45-degree field of view; CFP — 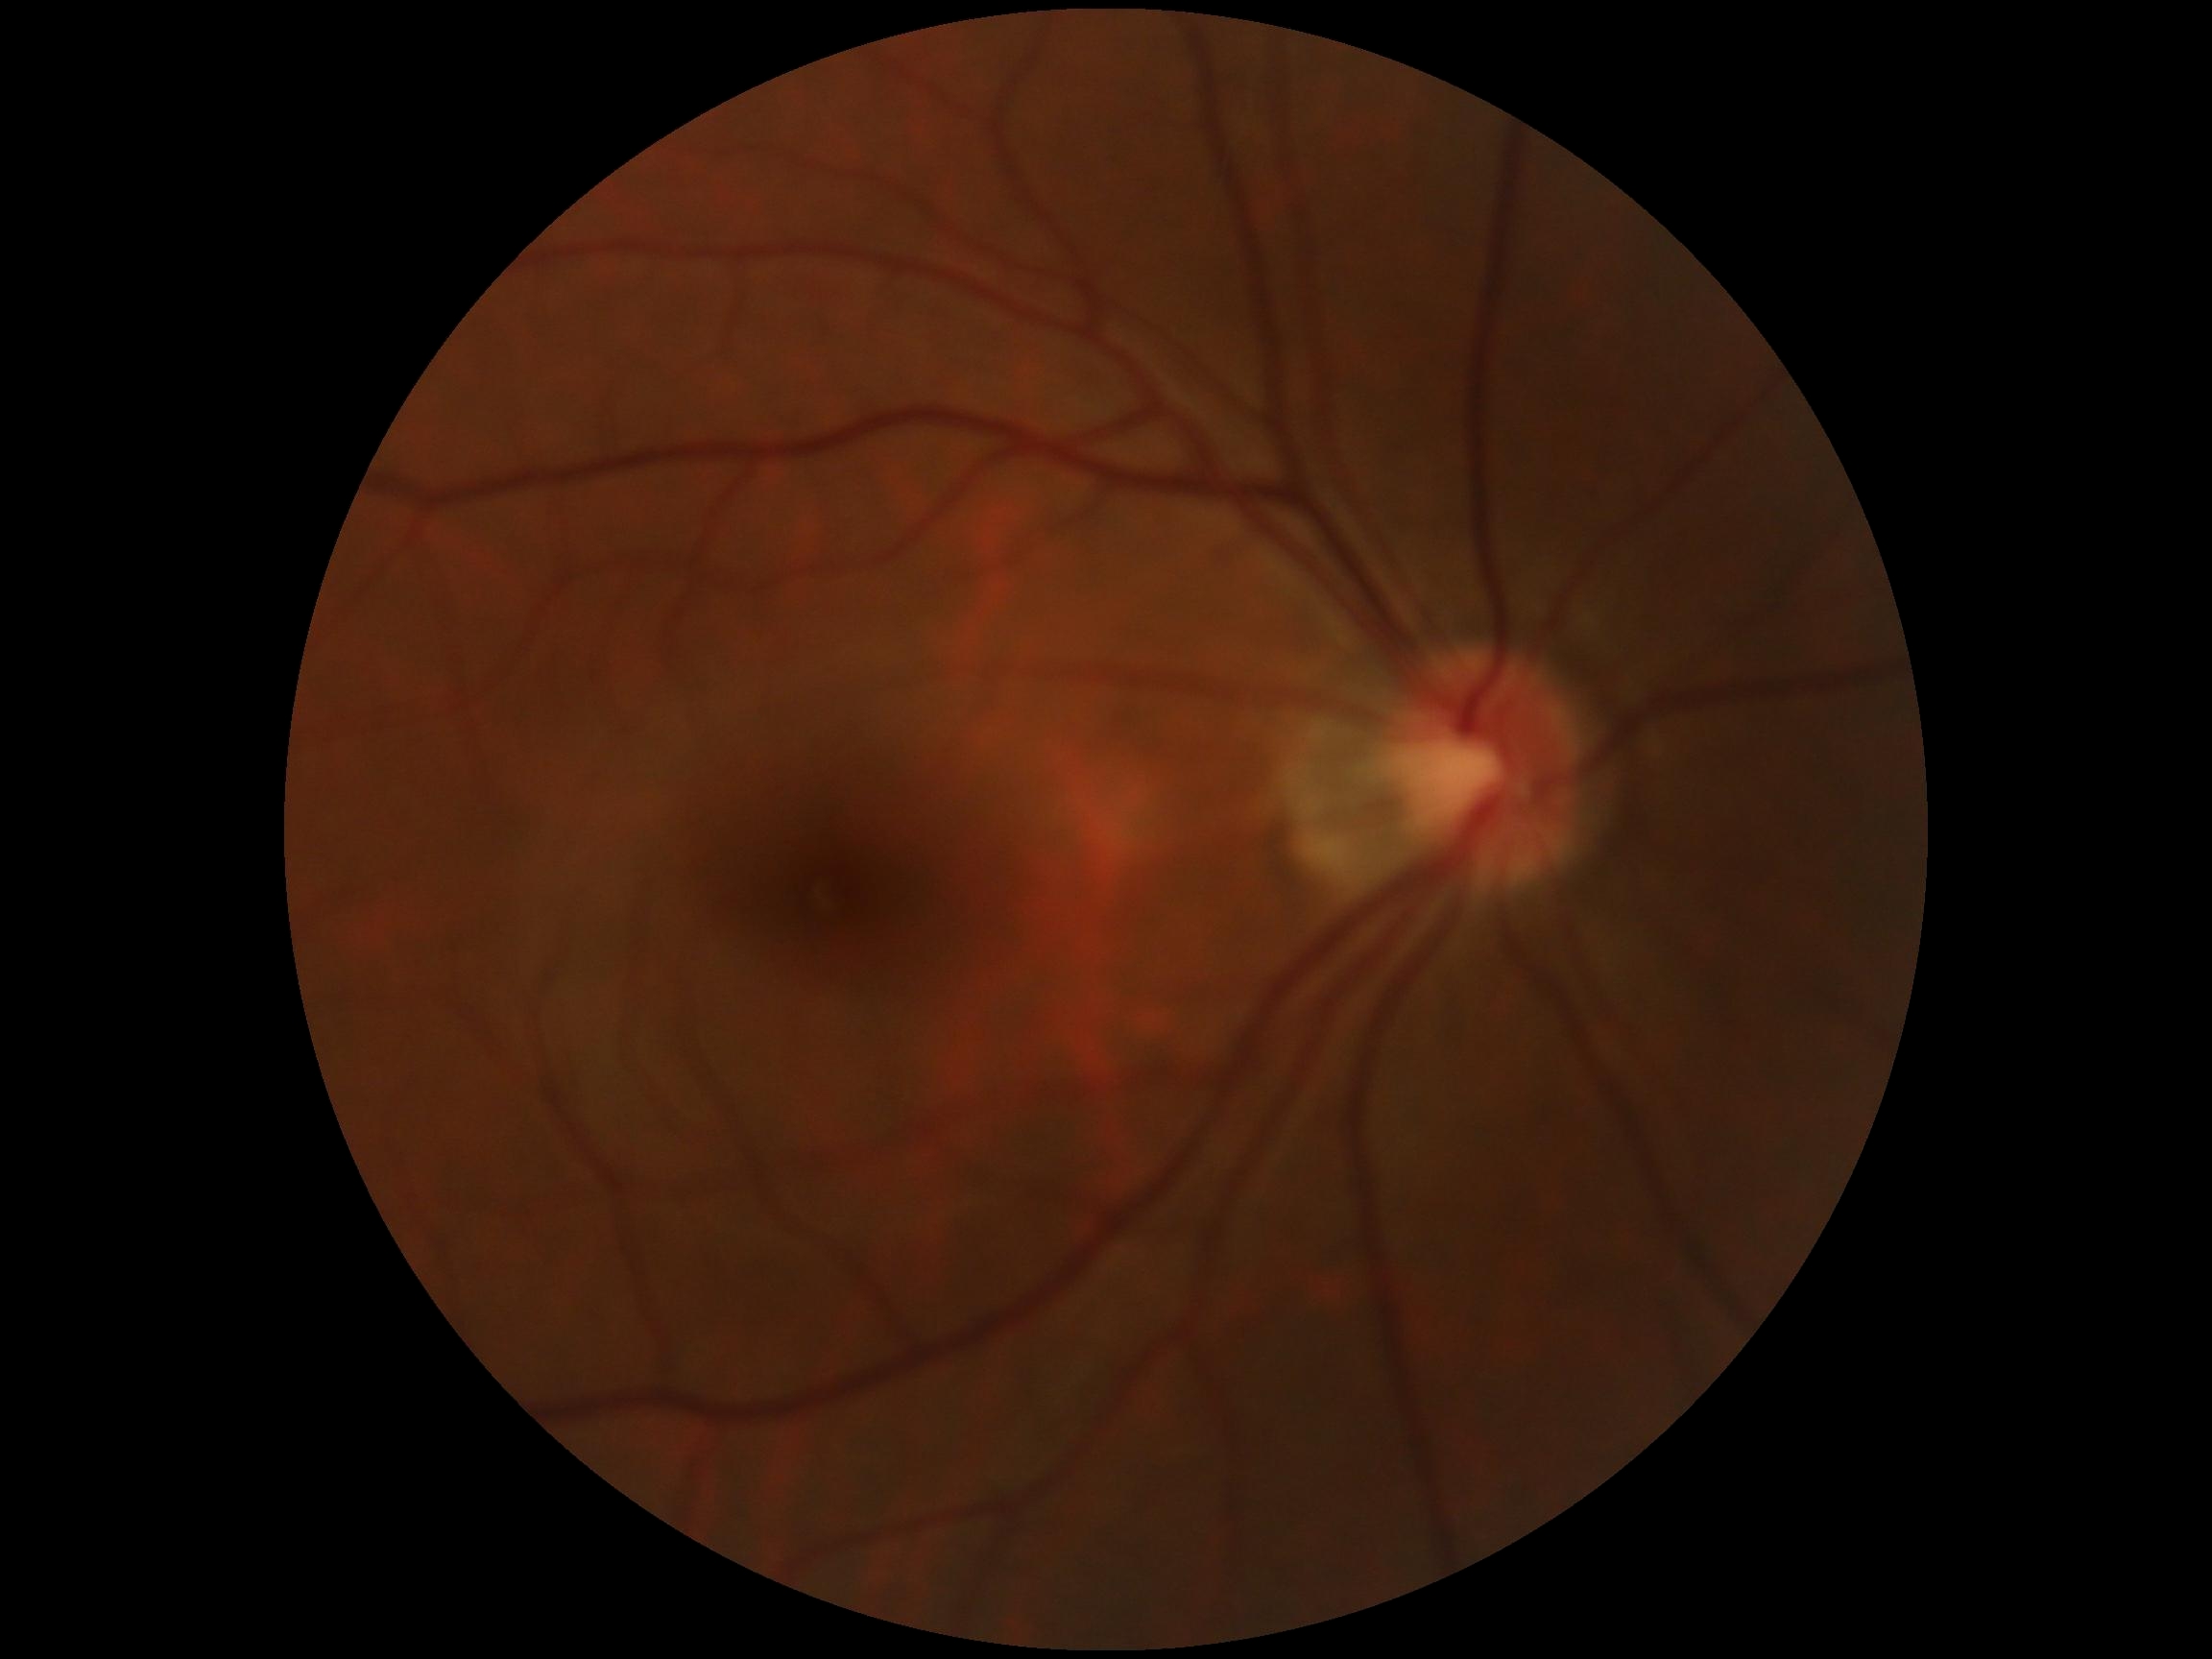 DR is 0 — no visible signs of diabetic retinopathy.